640x480 · wide-field fundus photograph from neonatal ROP screening · captured with the Clarity RetCam 3 (130° field of view): 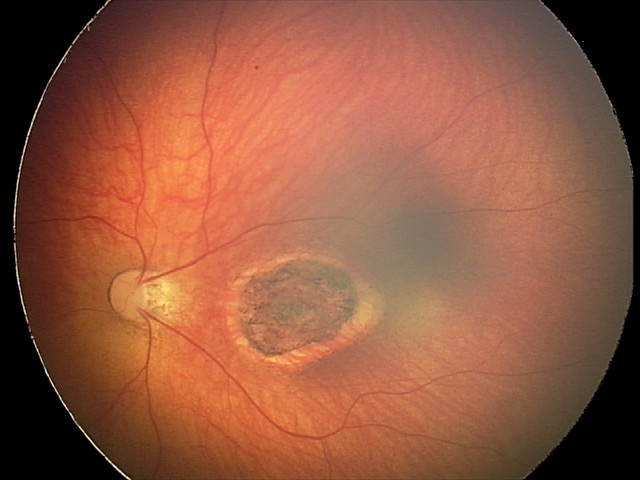
From an examination with diagnosis of toxoplasmosis chorioretinitis.